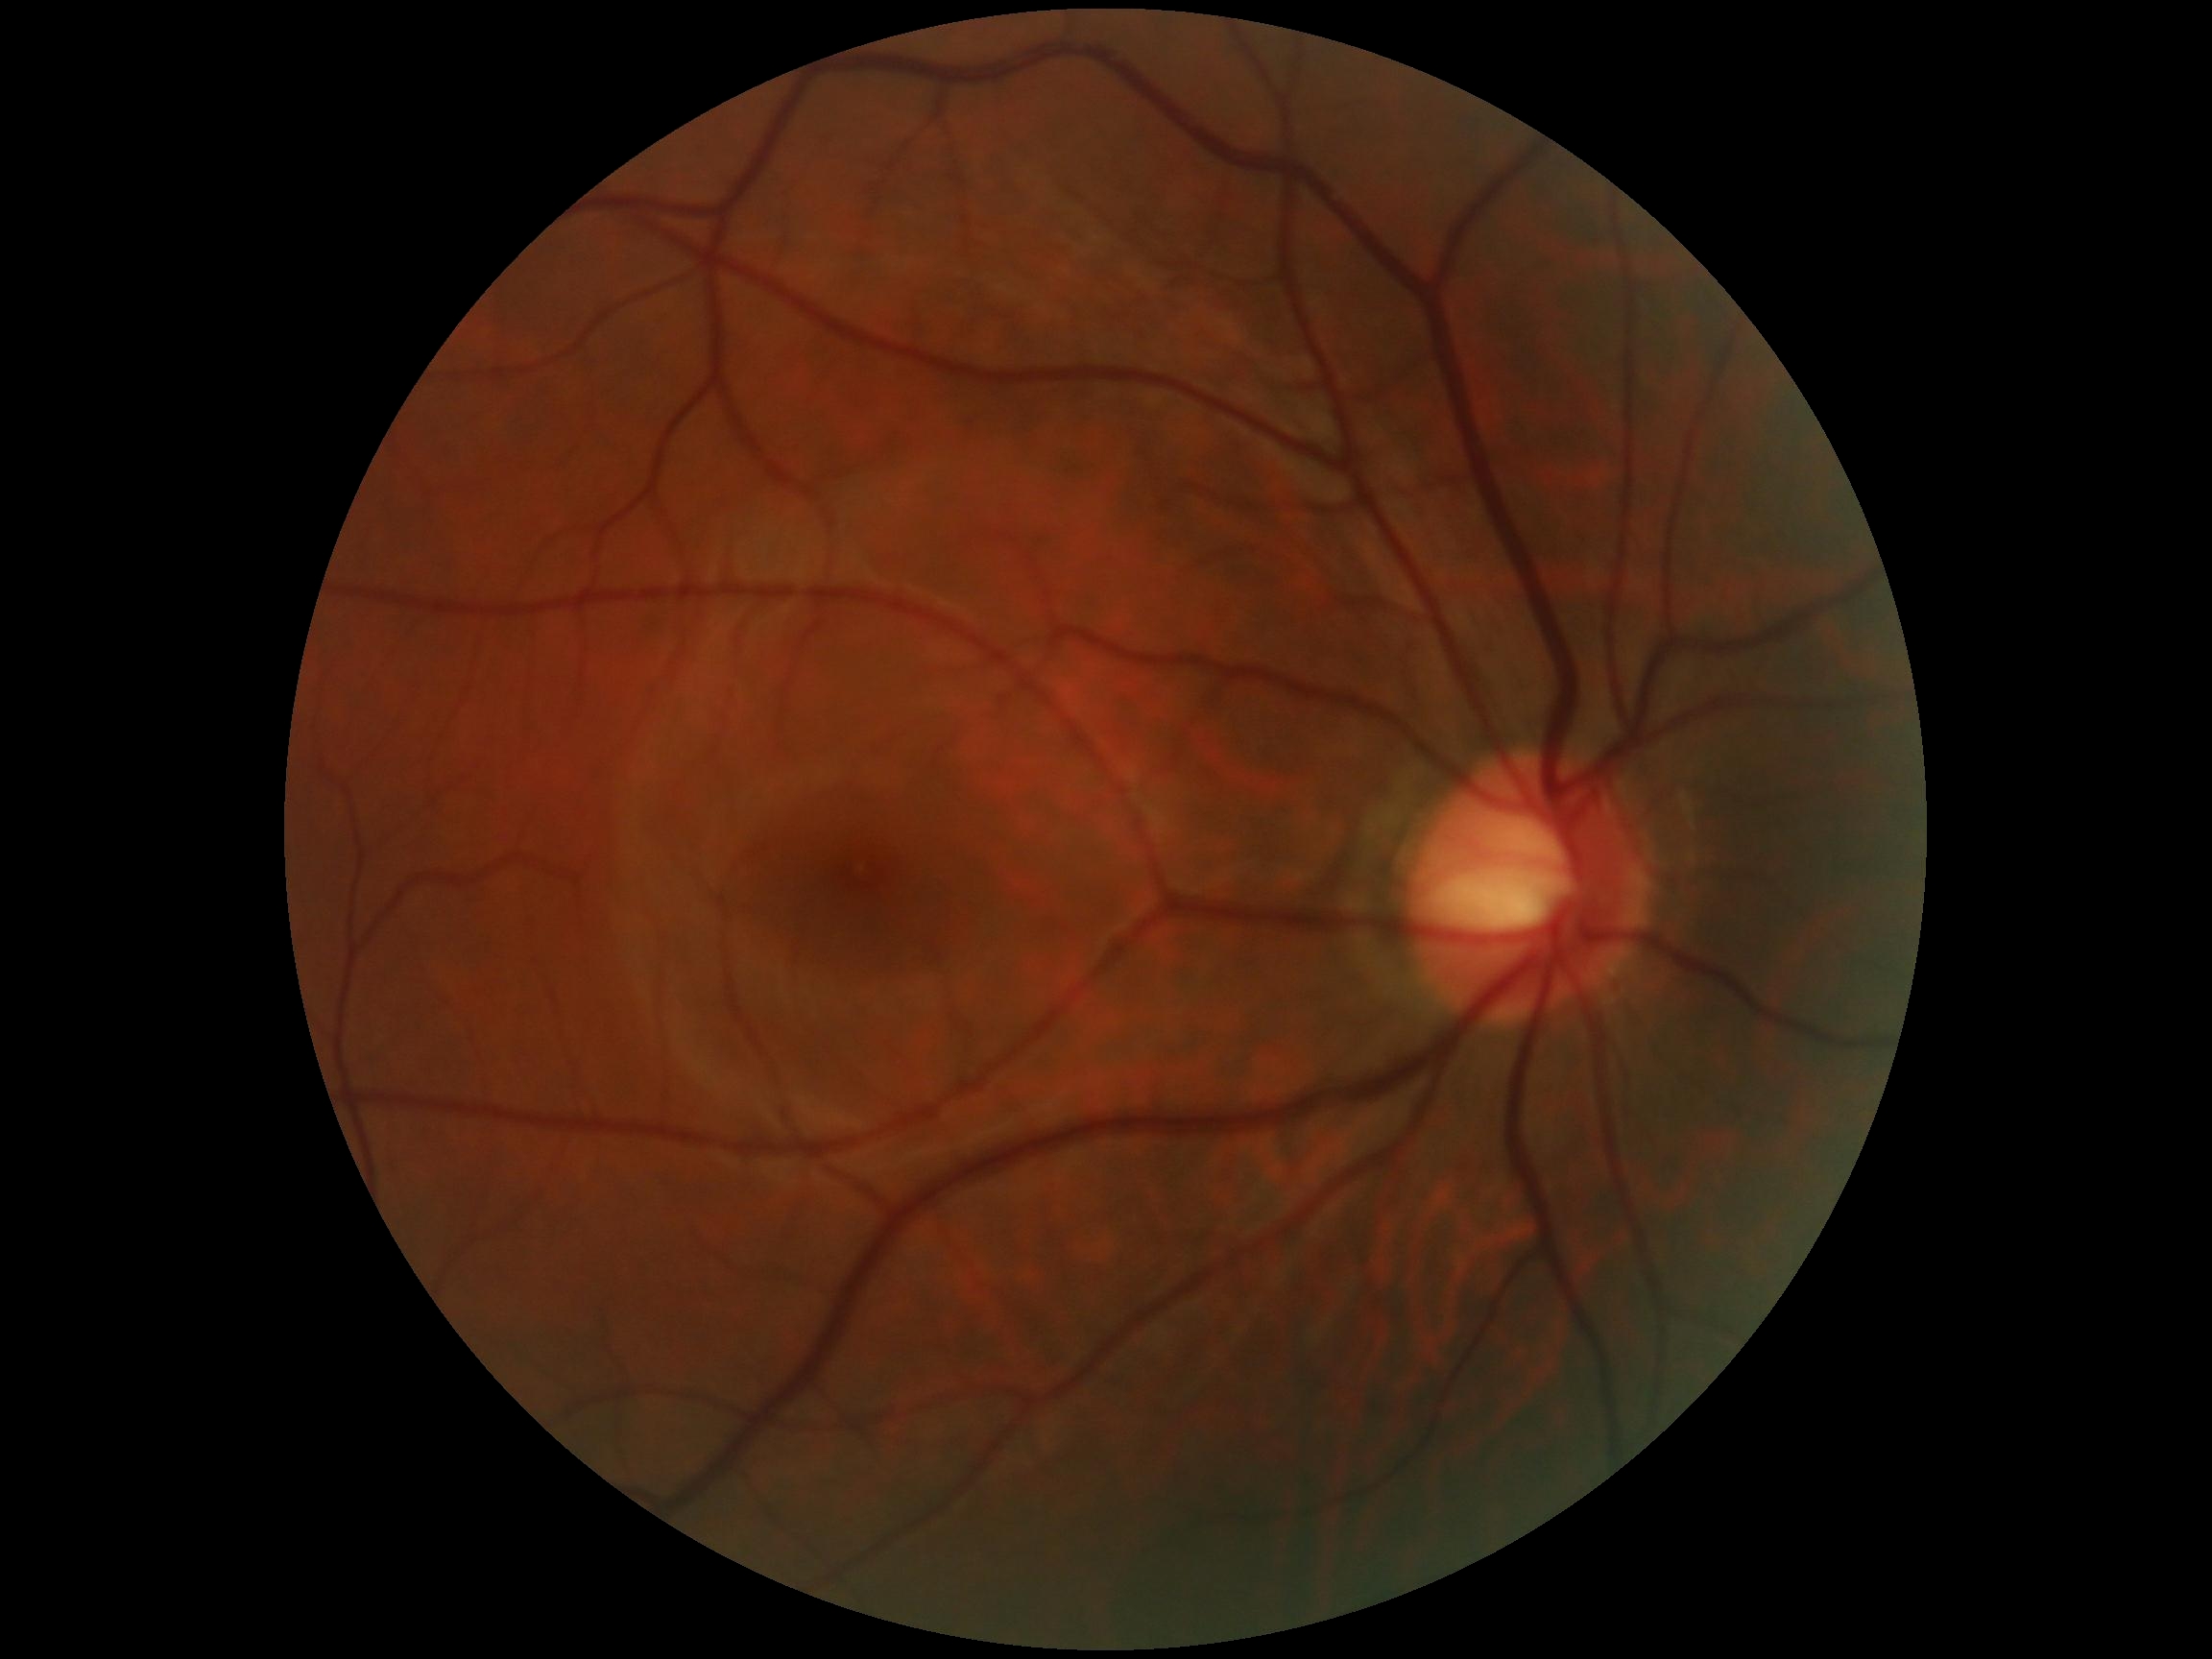

Diabetic retinopathy (DR): no apparent retinopathy (grade 0).
No DR findings.